45-degree field of view · color fundus image
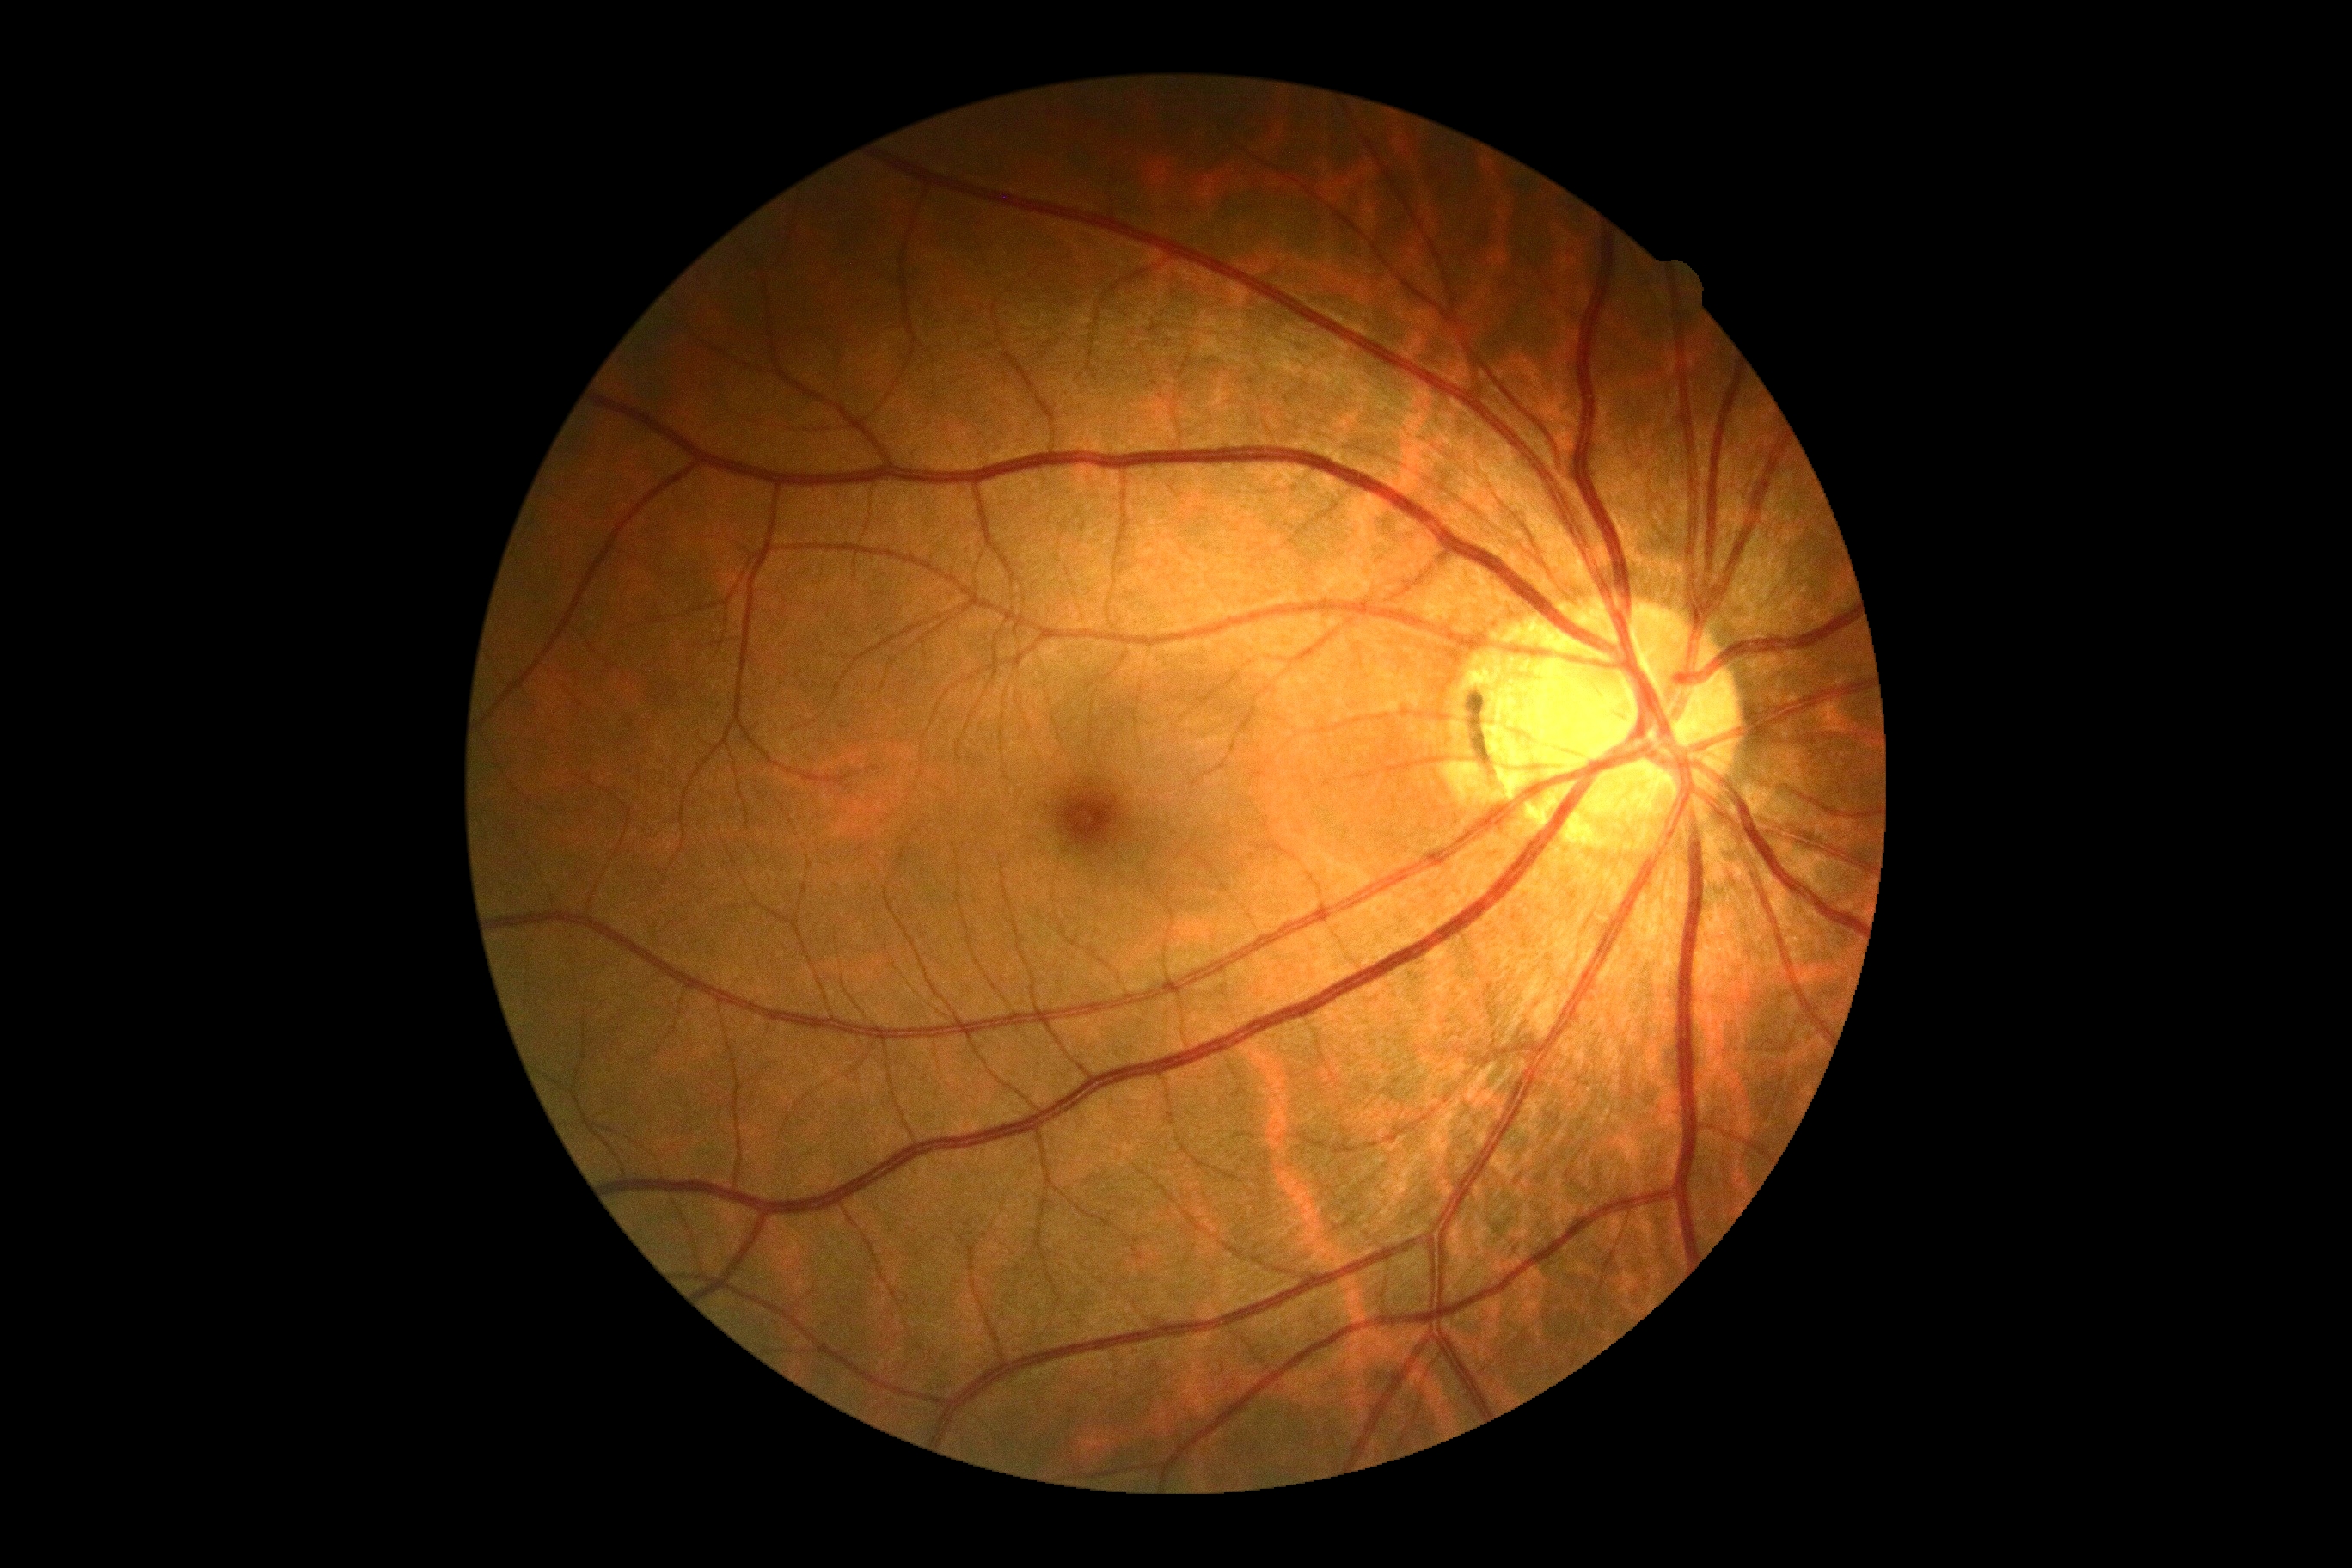
Findings:
* DR impression: no DR findings
* DR severity: 0/4 — no visible signs of diabetic retinopathy